Modified Davis grading, 45-degree field of view, fundus photo.
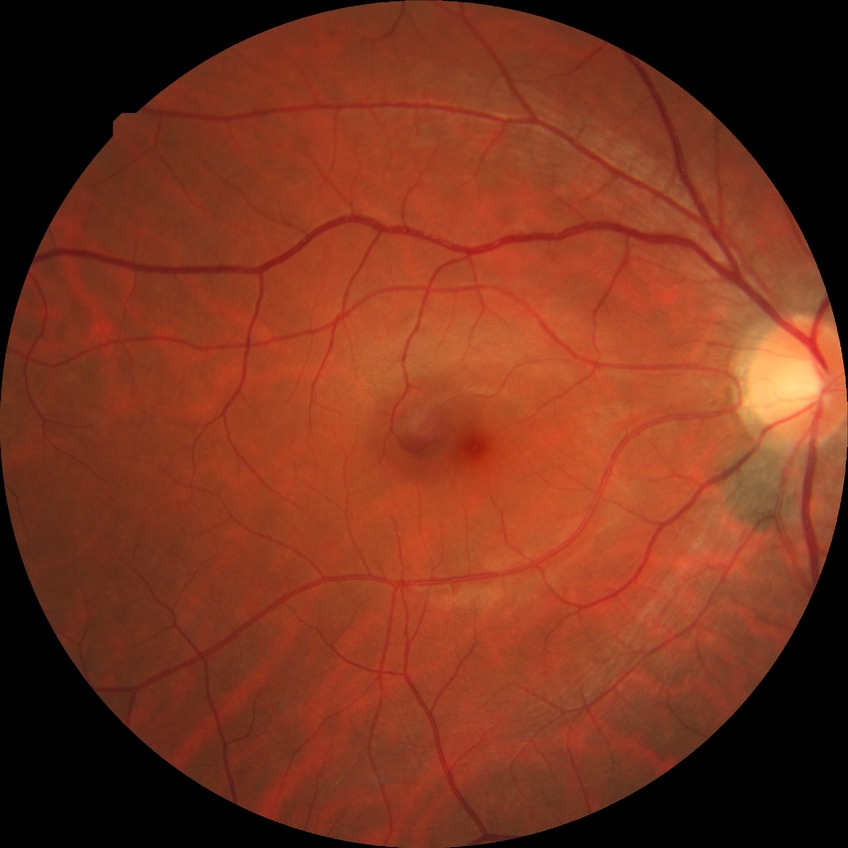 diabetic retinopathy (DR)=NDR (no diabetic retinopathy).